848x848px · 45-degree field of view · NIDEK AFC-230 · modified Davis grading · no pharmacologic dilation · posterior pole photograph: 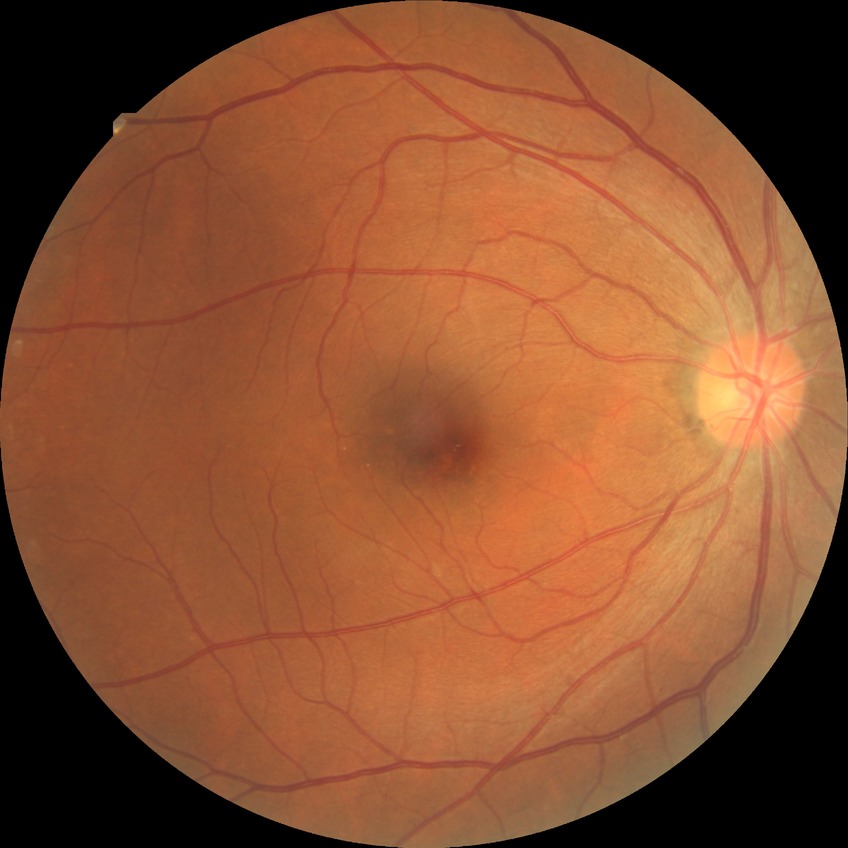
retinopathy grade = no diabetic retinopathy.